2352x1568px · FOV: 45 degrees · fundus photo — 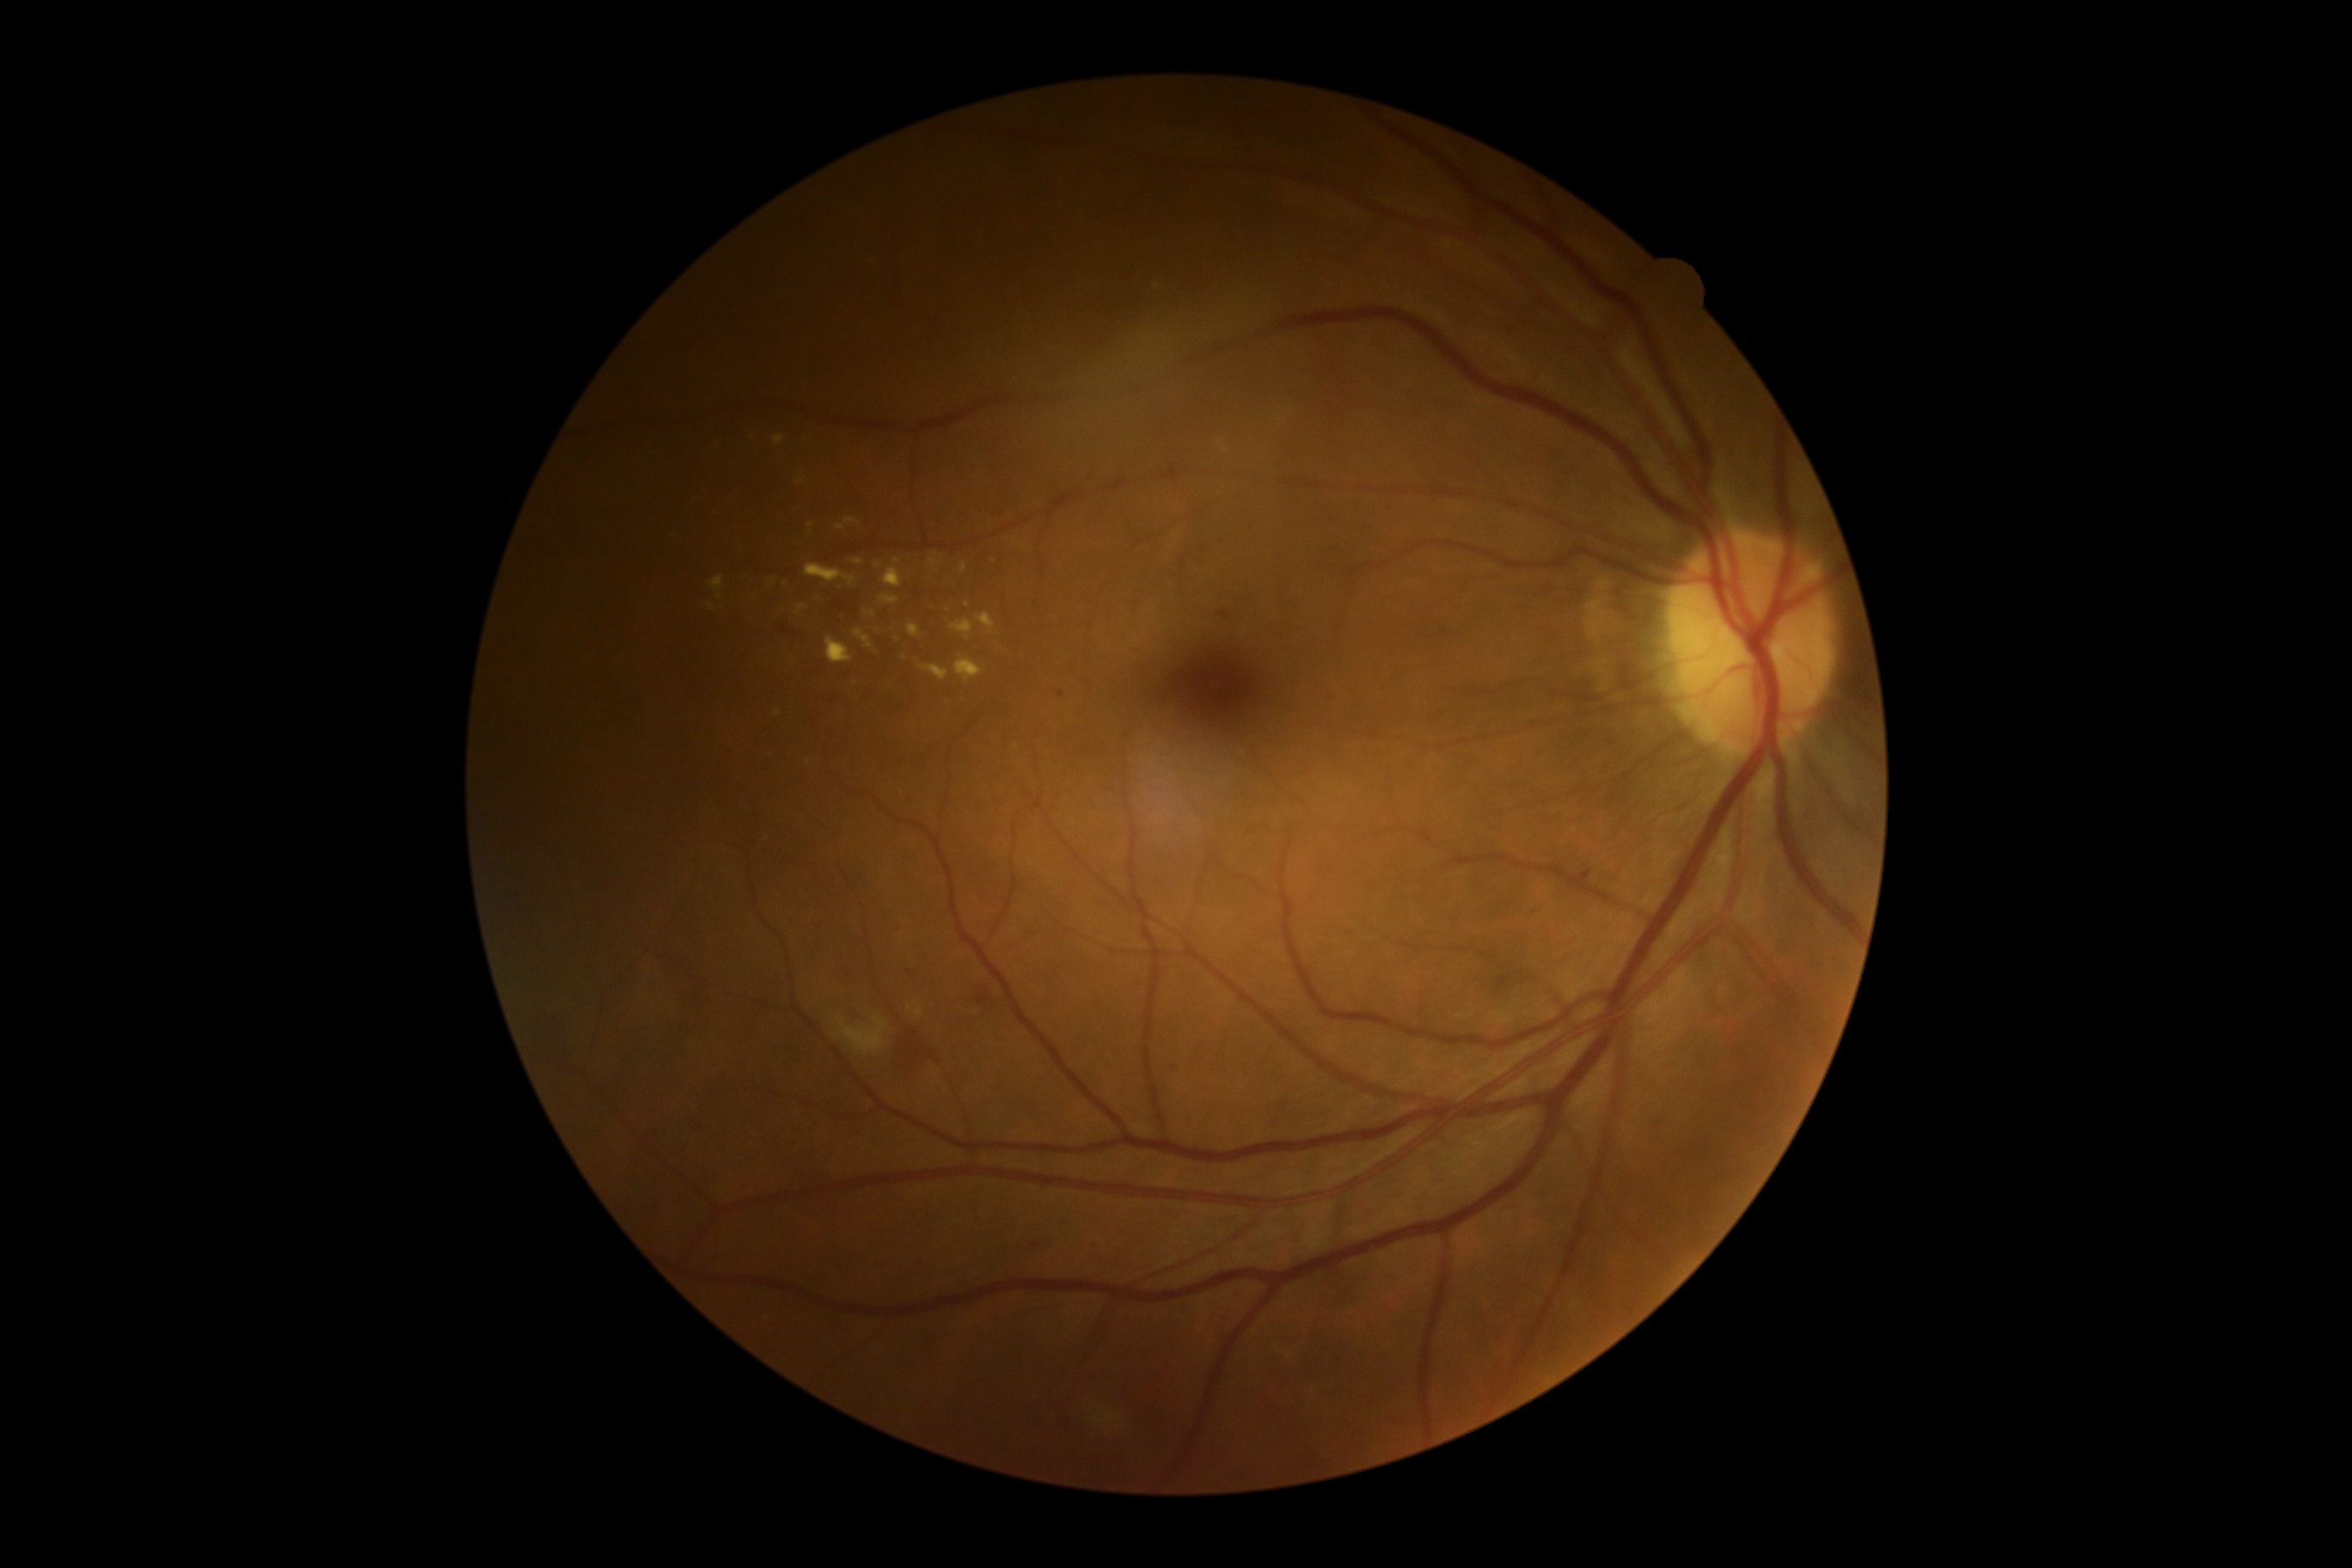

Diabetic retinopathy (DR) is grade 2 (moderate NPDR) — more than just microaneurysms but less than severe NPDR
Selected lesions:
hard exudates (EXs) (more not shown): 797 604 807 615 | 852 560 864 567 | 826 637 854 665 | 854 630 873 647 | 952 618 974 640 | 879 596 898 604
Smaller EXs around (782,612) | (801,482) | (914,661) | (693,500) | (897,562) | (897,638) | (873,614) | (1017,747) | (778,713) | (968,605)